DR severity per modified Davis staging
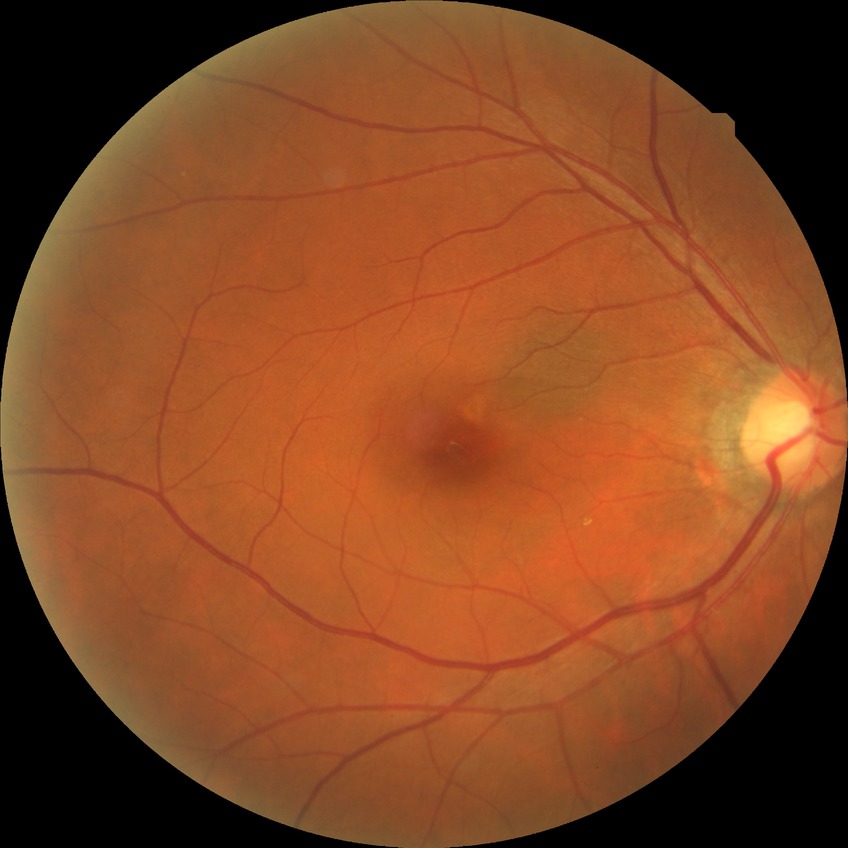

  davis_grade: no diabetic retinopathy